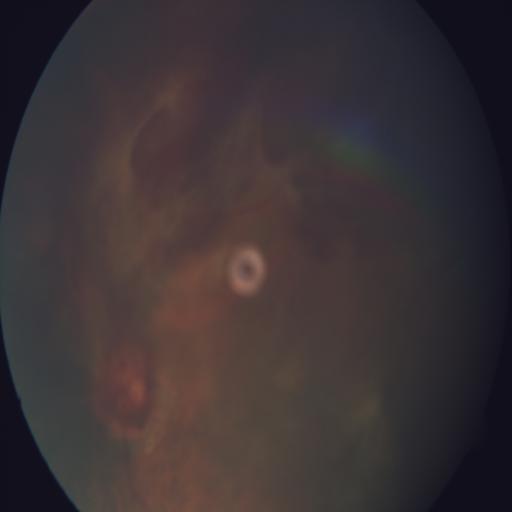
Color fundus photograph showing preretinal hemorrhage and hemorrhagic retinopathy.